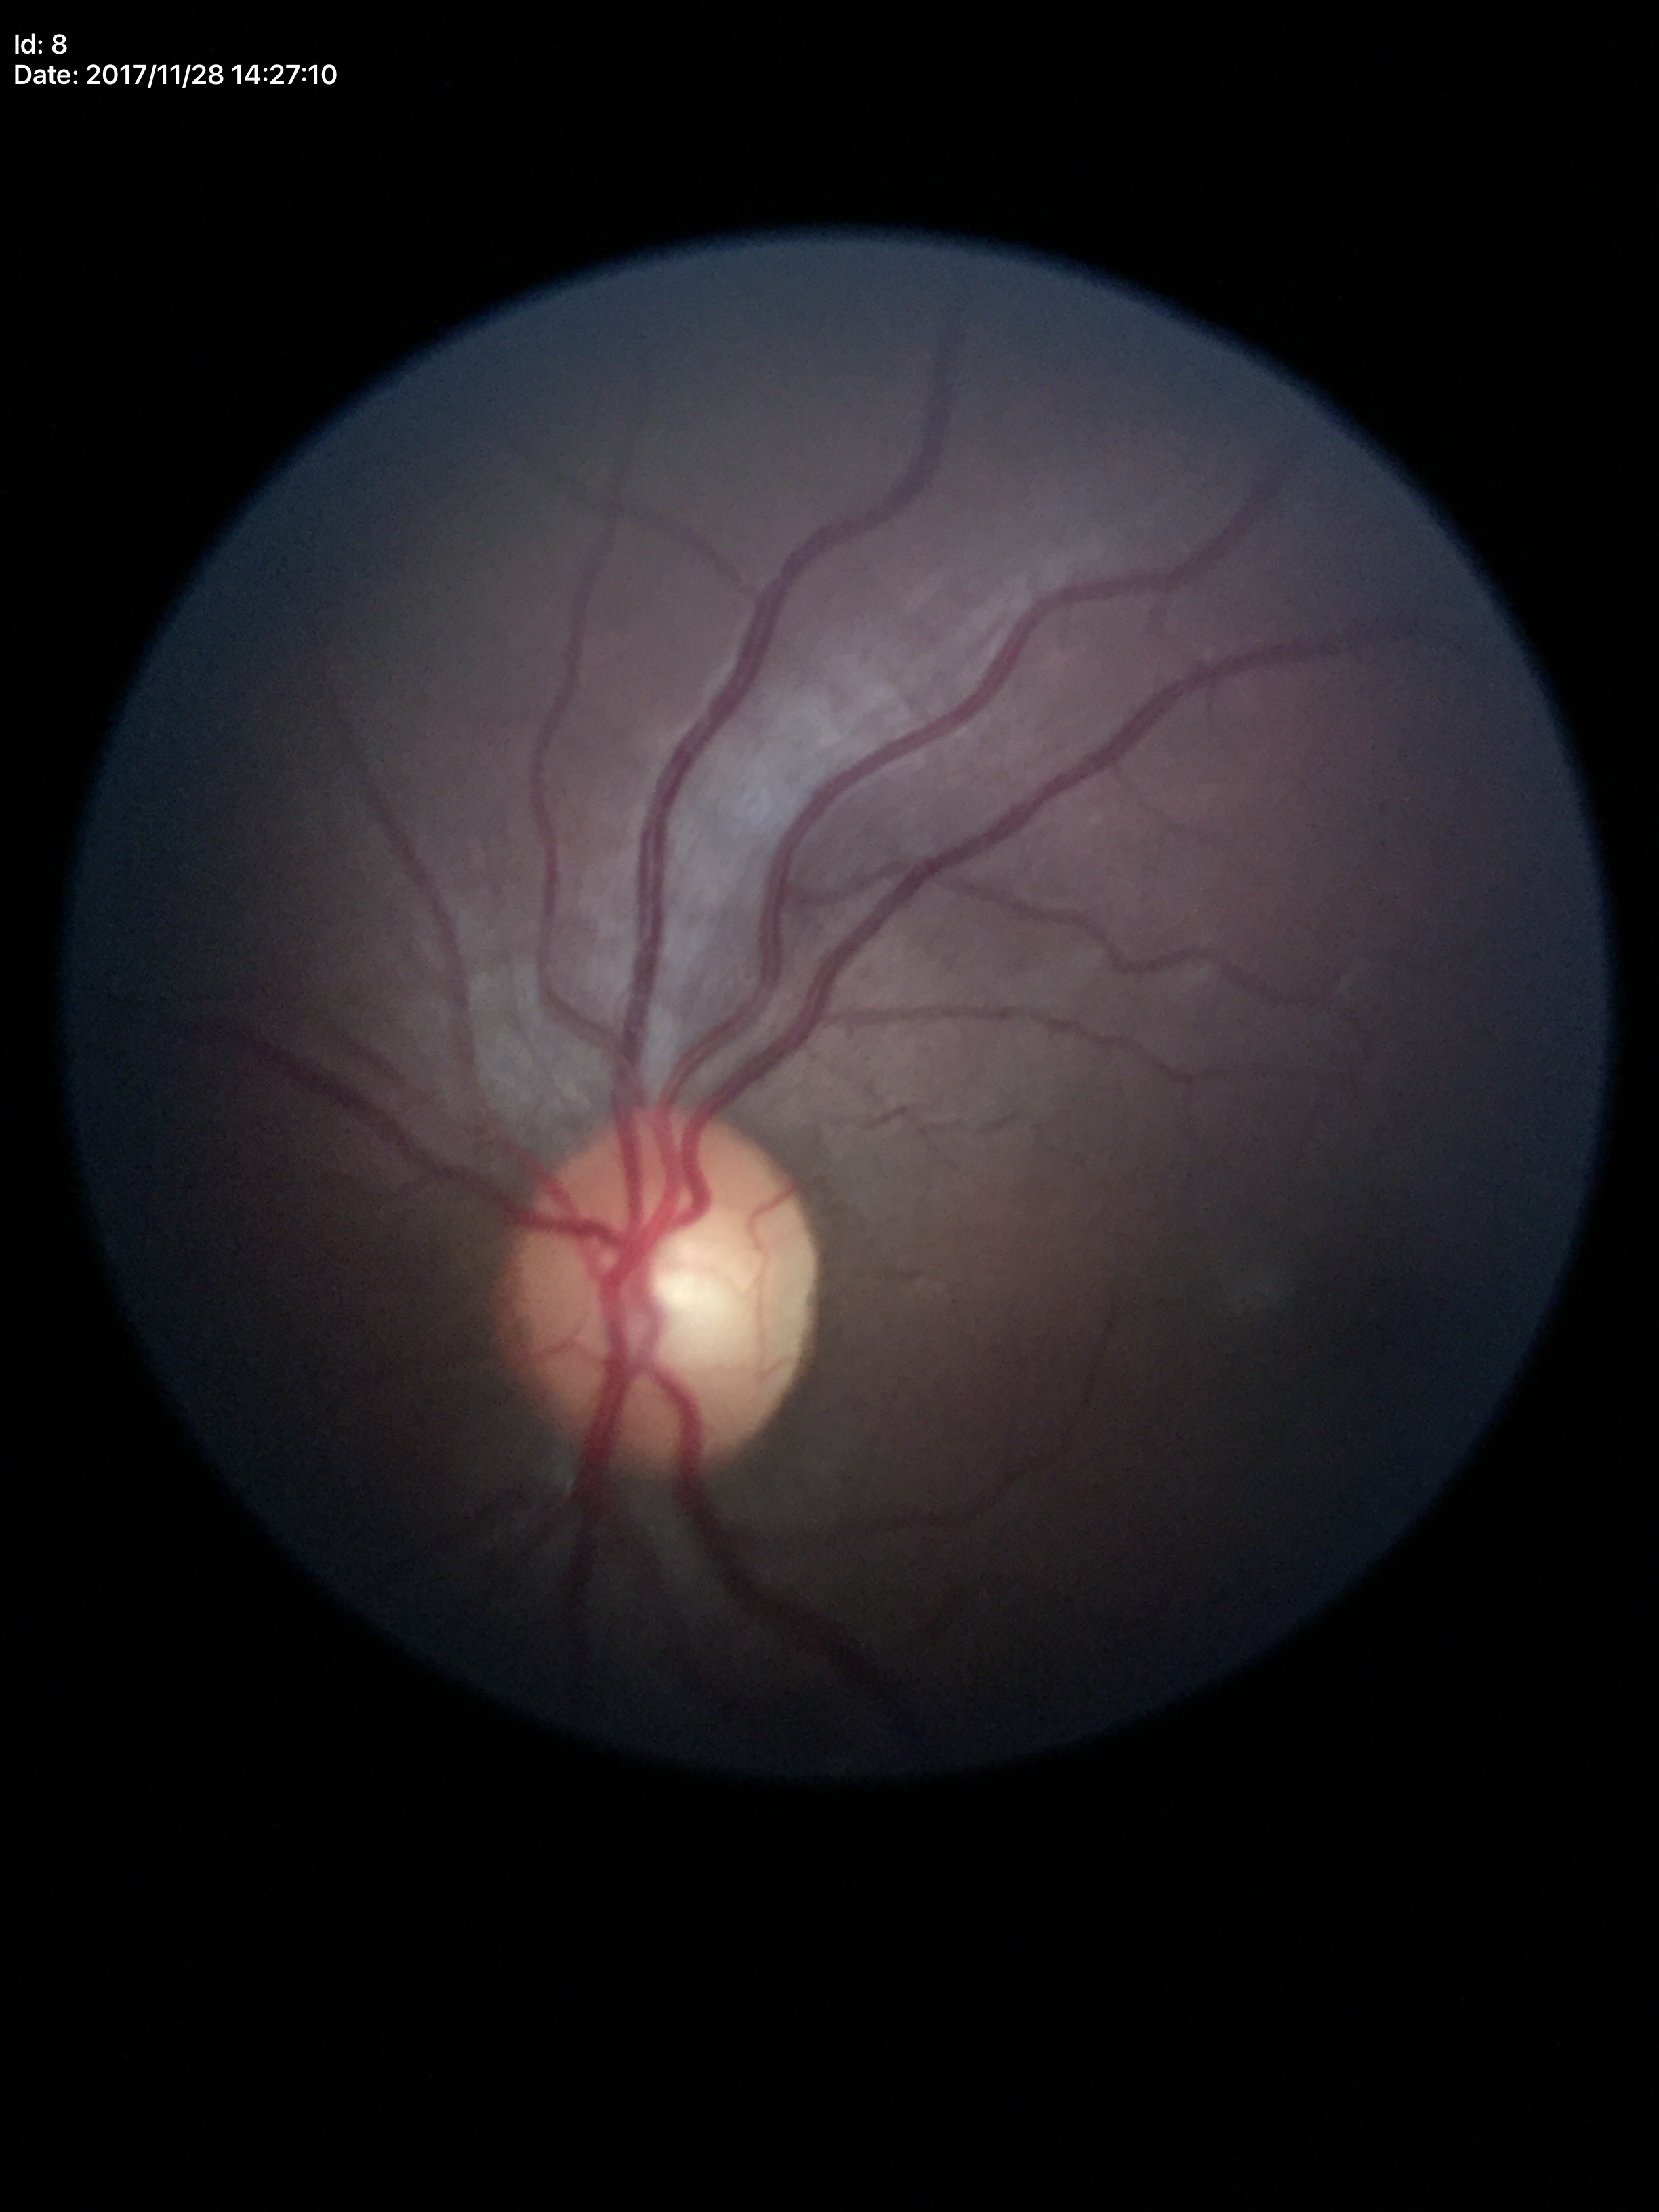

Glaucoma screening: not suspect. Horizontal cup-disc ratio: 0.57. Vertical C/D ratio is 0.56.